1240x1240. Wide-field fundus photograph from neonatal ROP screening.
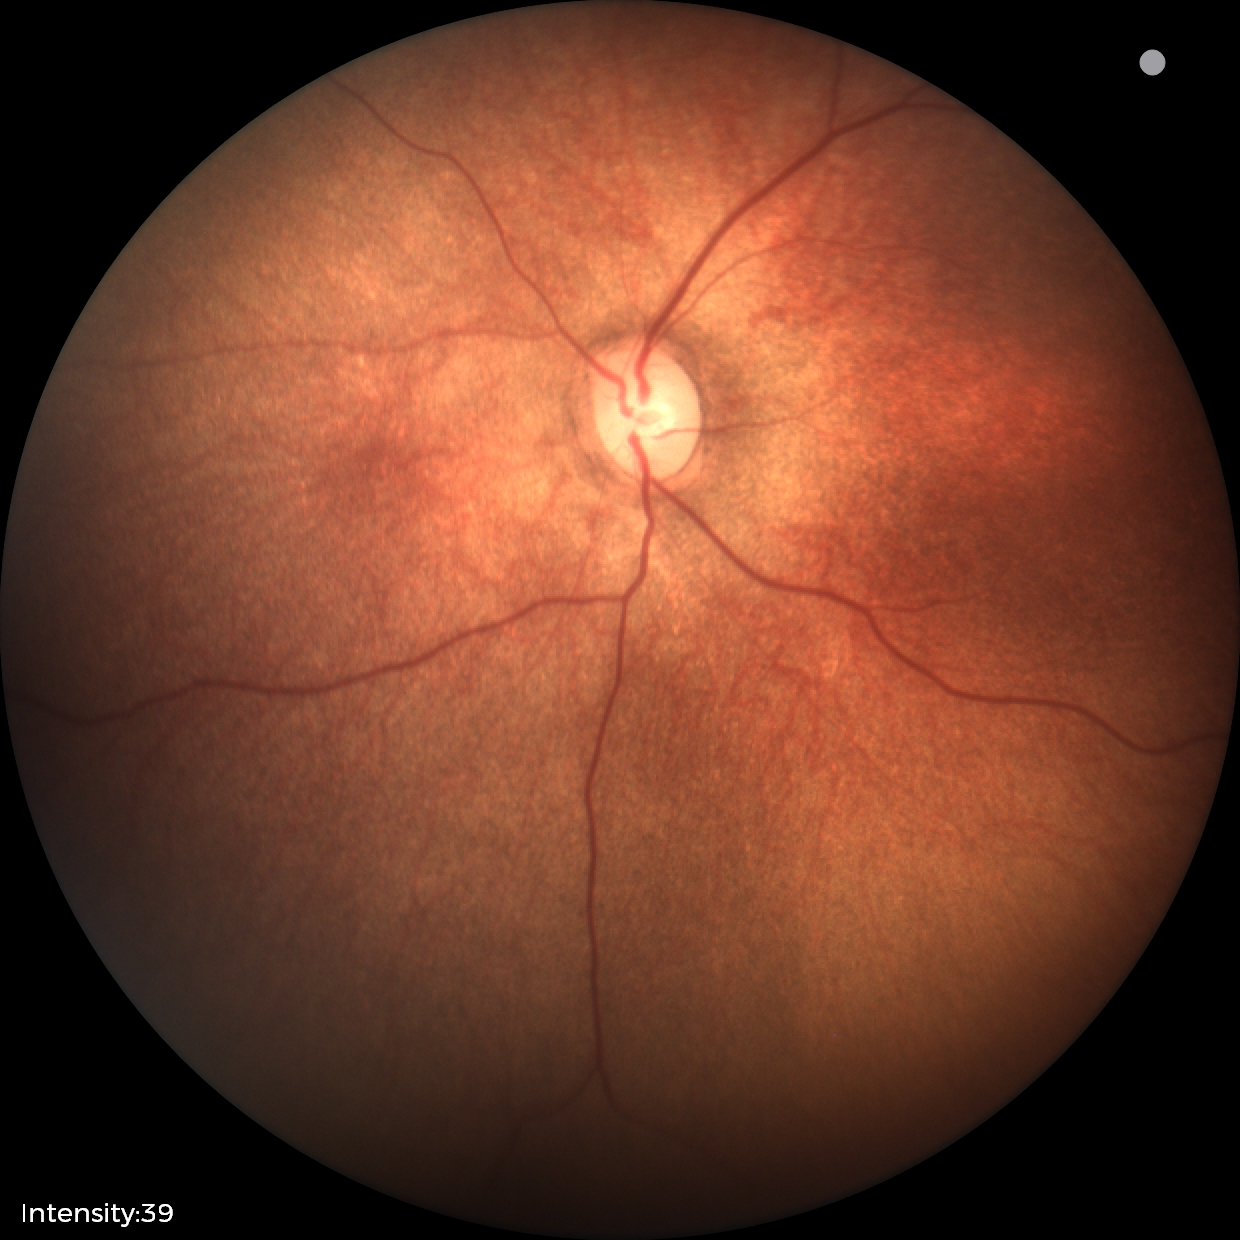 Q: What was the screening finding?
A: physiological retinal finding